Acquired with a NIDEK AFC-230, 848x848px, 45° FOV, nonmydriatic.
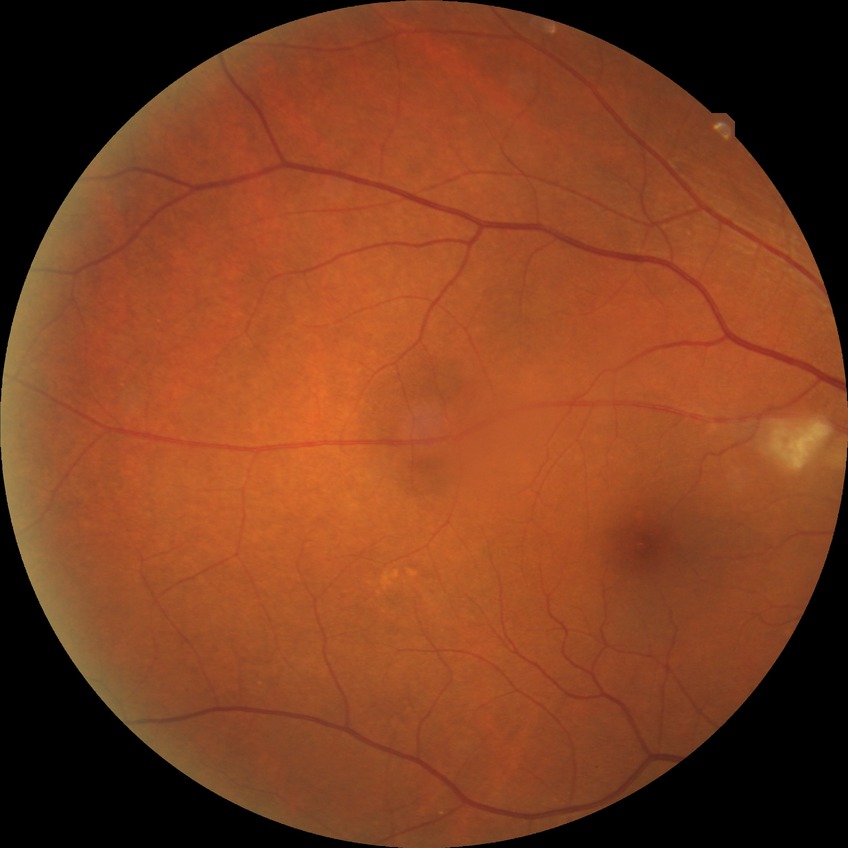

Retinopathy stage is no diabetic retinopathy.